Fundus photo · image size 2352x1568 · 45° field of view: 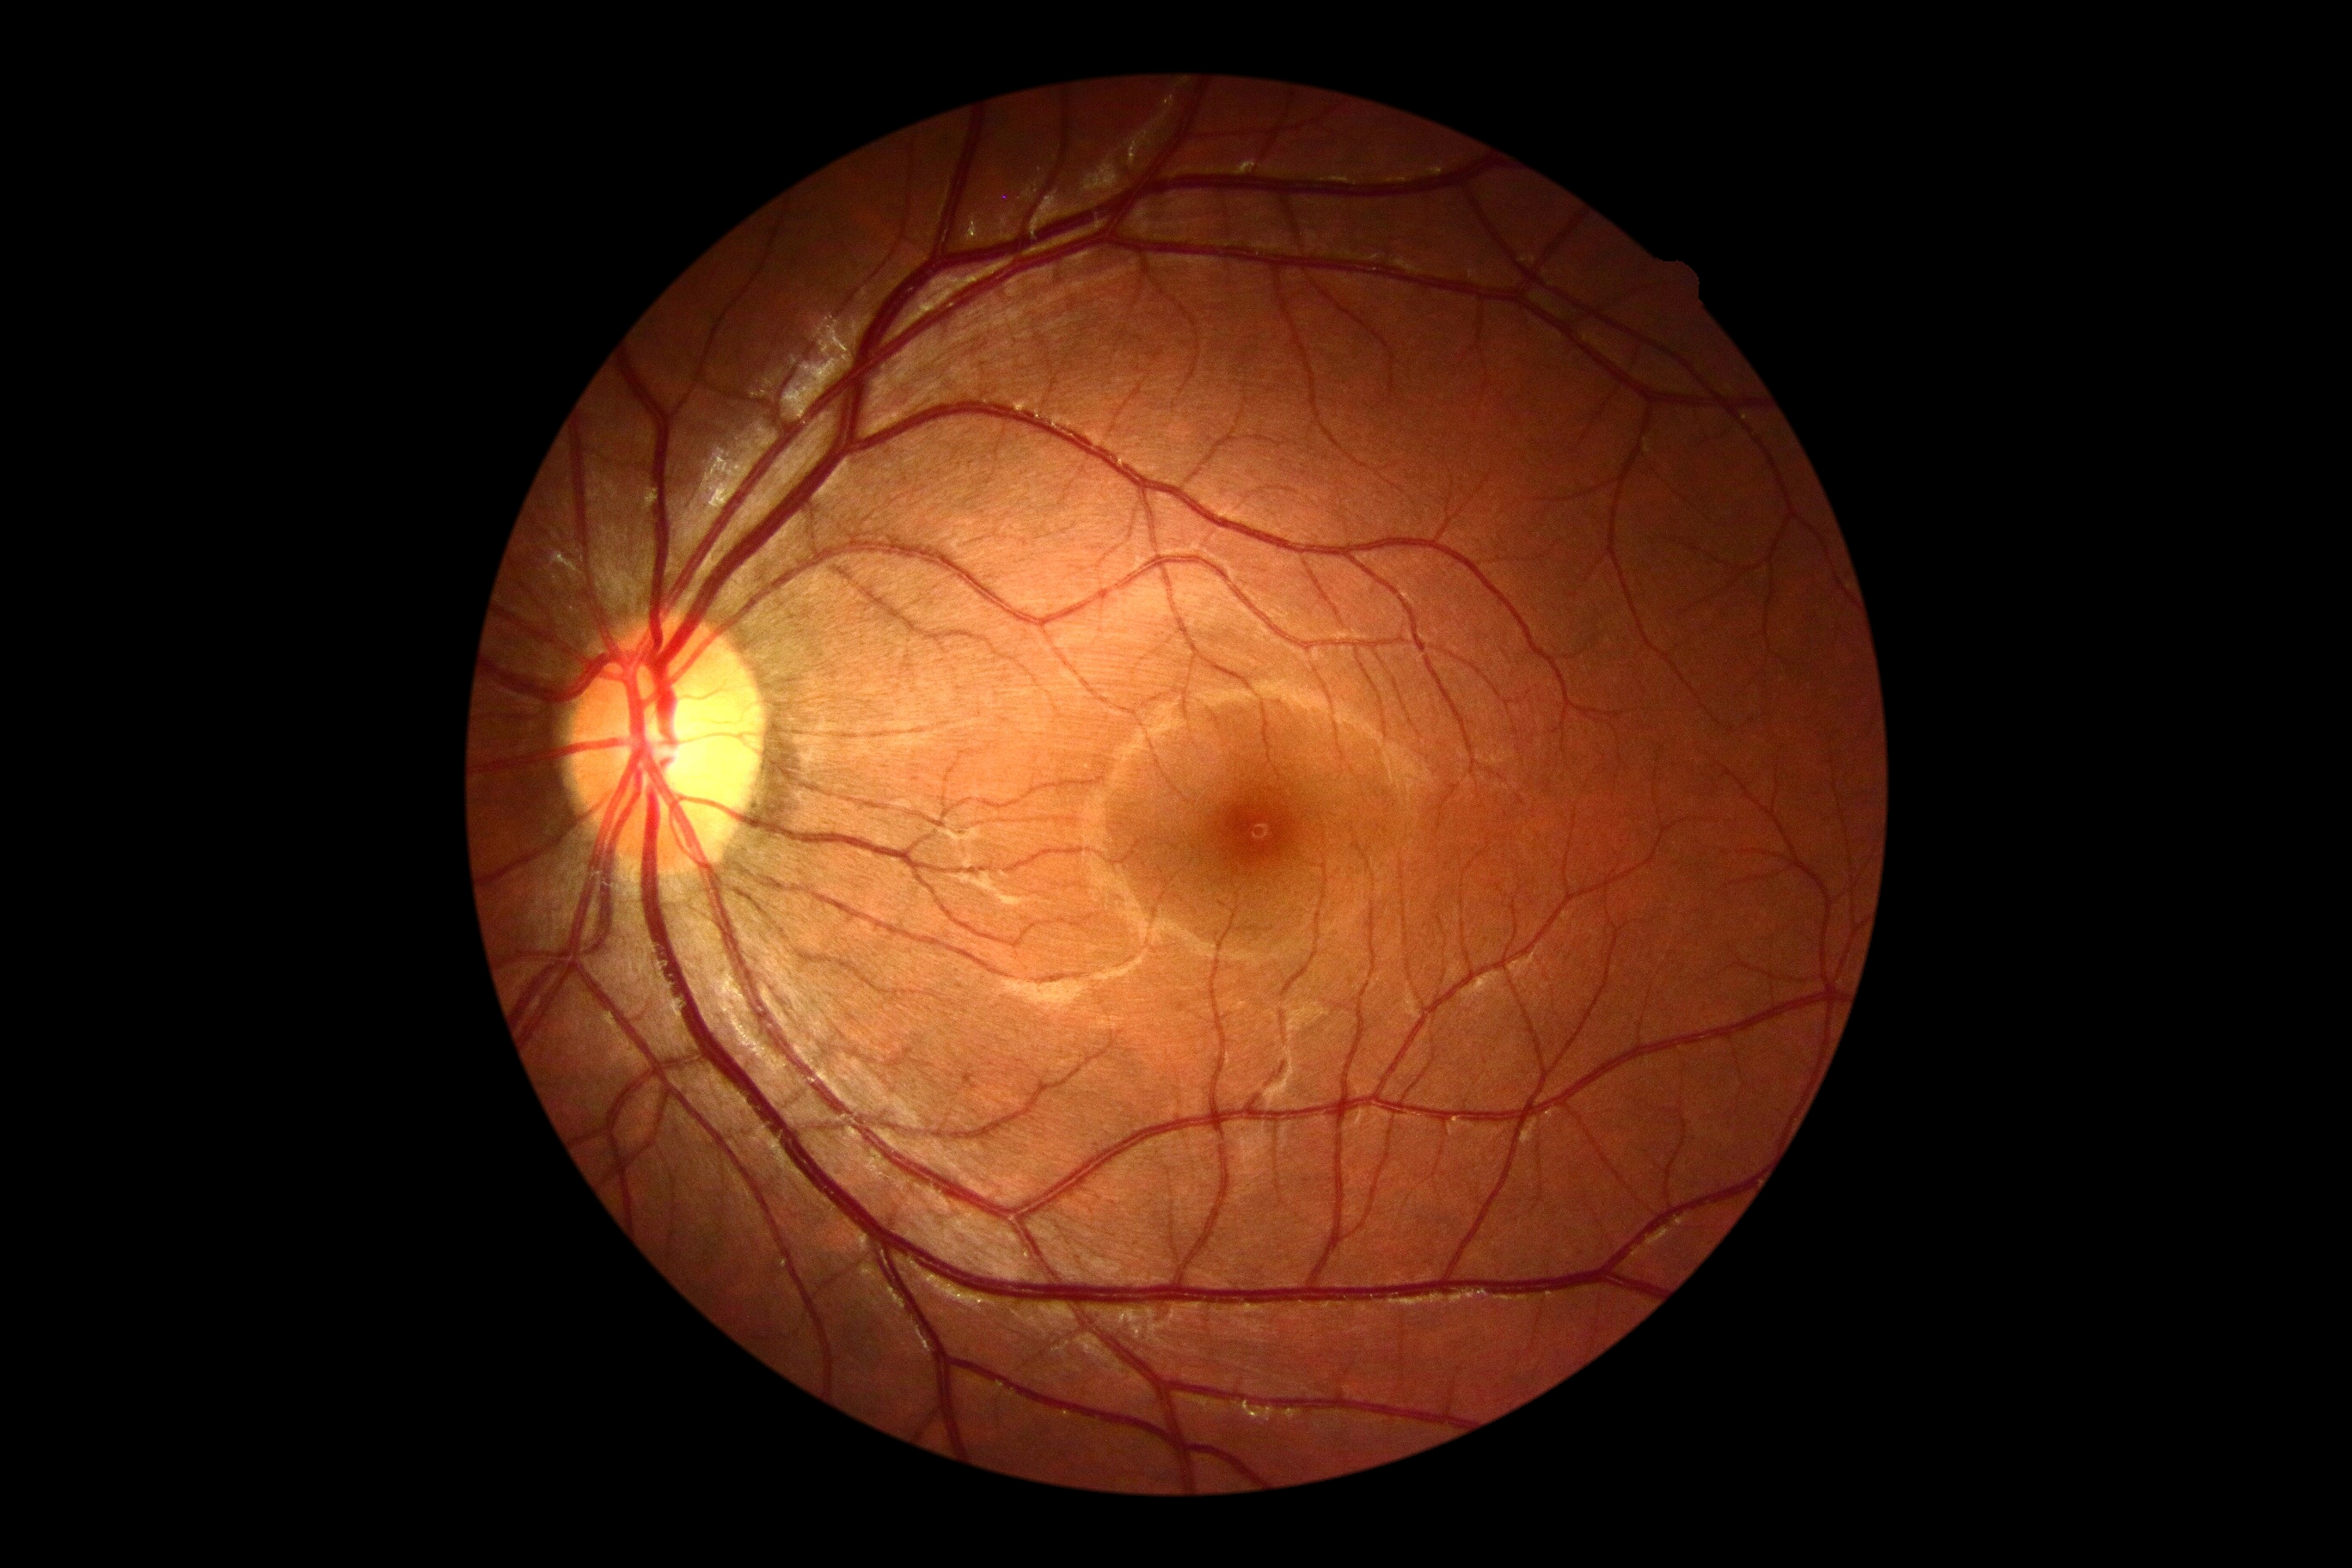 DR severity@grade 0 (no apparent retinopathy) — no visible signs of diabetic retinopathy.